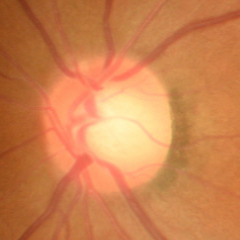

Q: Glaucoma assessment?
A: No glaucoma.